Wide-field fundus photograph from neonatal ROP screening; image size 1240x1240: 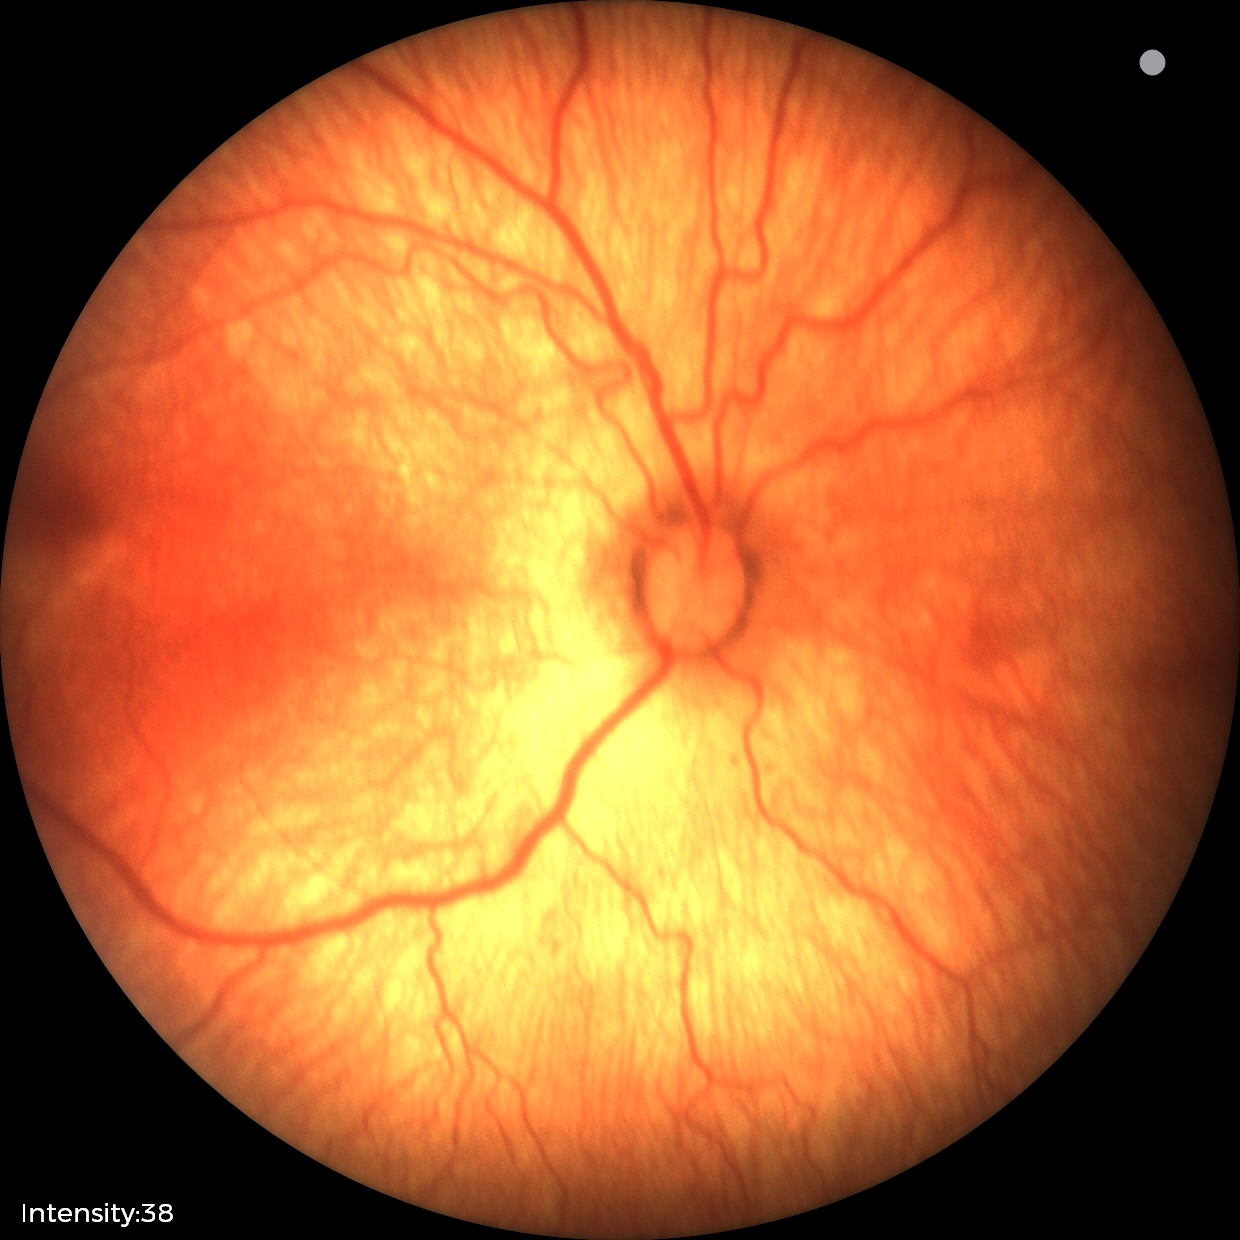

Plus disease: absent — posterior pole vessels without abnormal dilation or tortuosity | finding: status post ROP.